CFP.
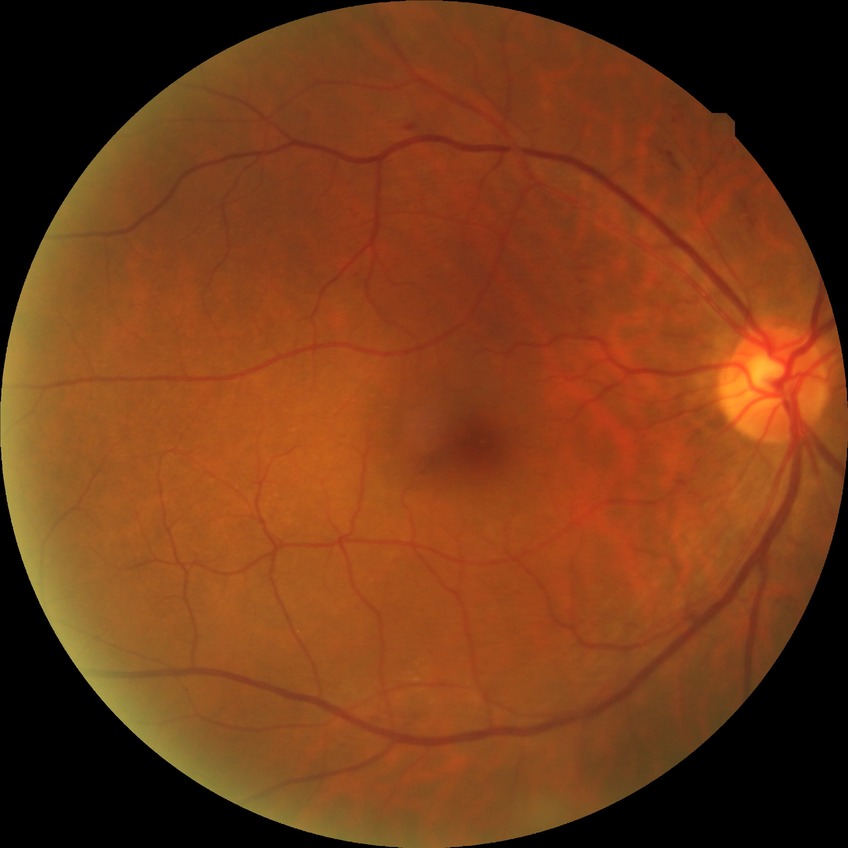

* diabetic retinopathy (DR): SDR (simple diabetic retinopathy)
* DR class: non-proliferative diabetic retinopathy